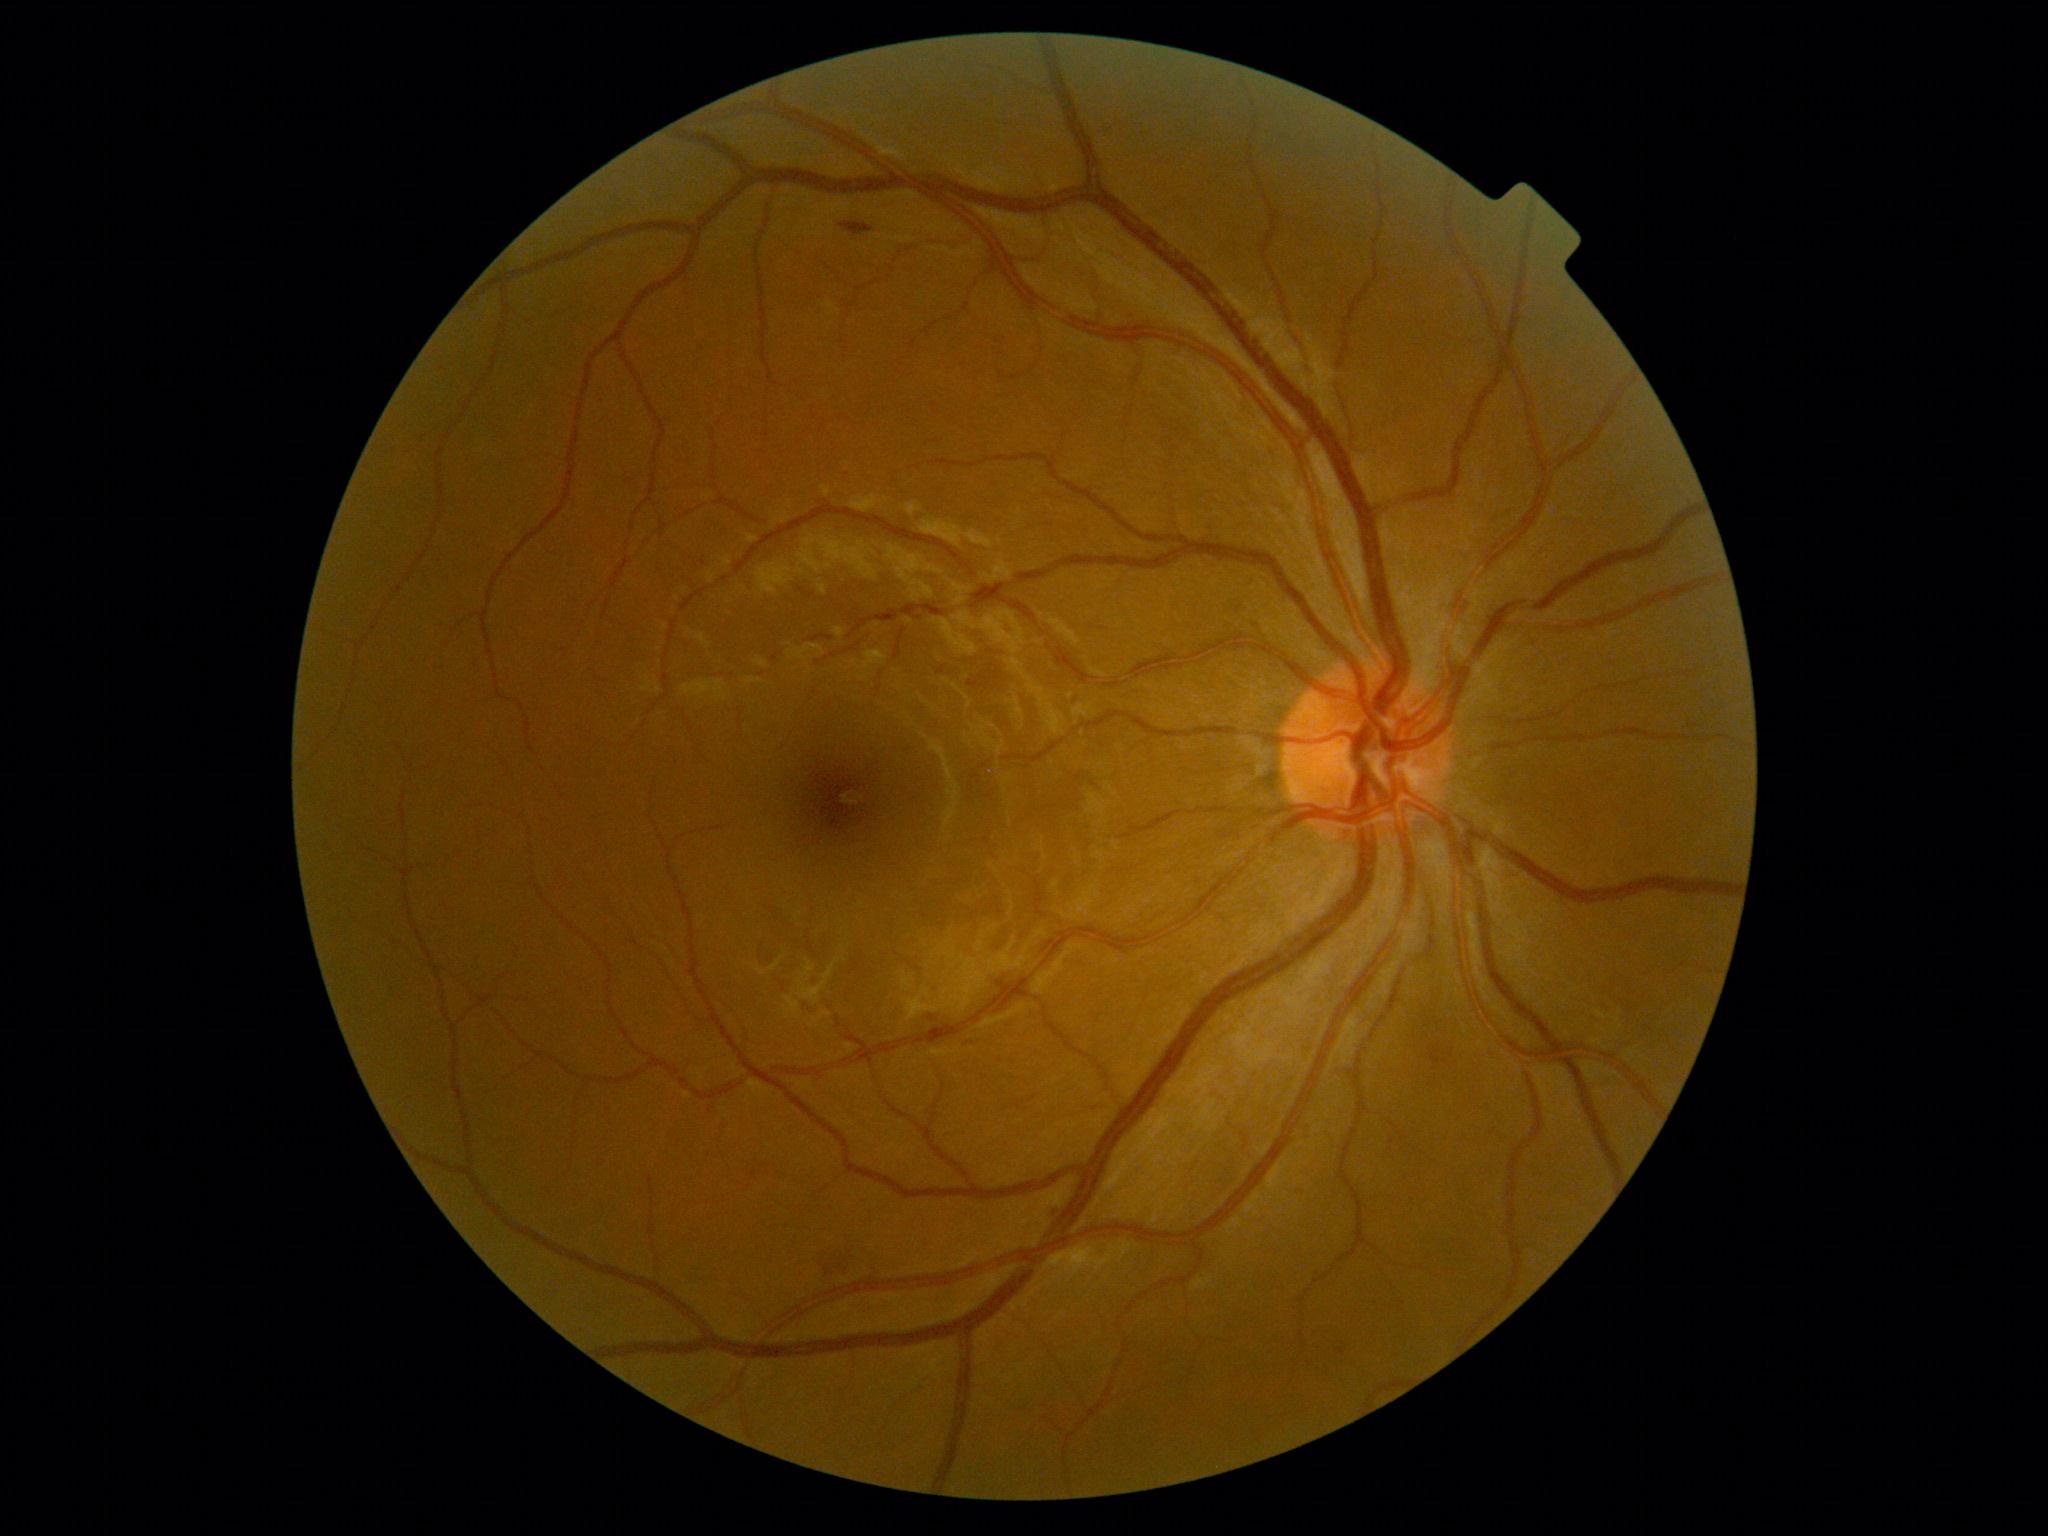
Diabetic retinopathy grade is 2 (moderate NPDR).